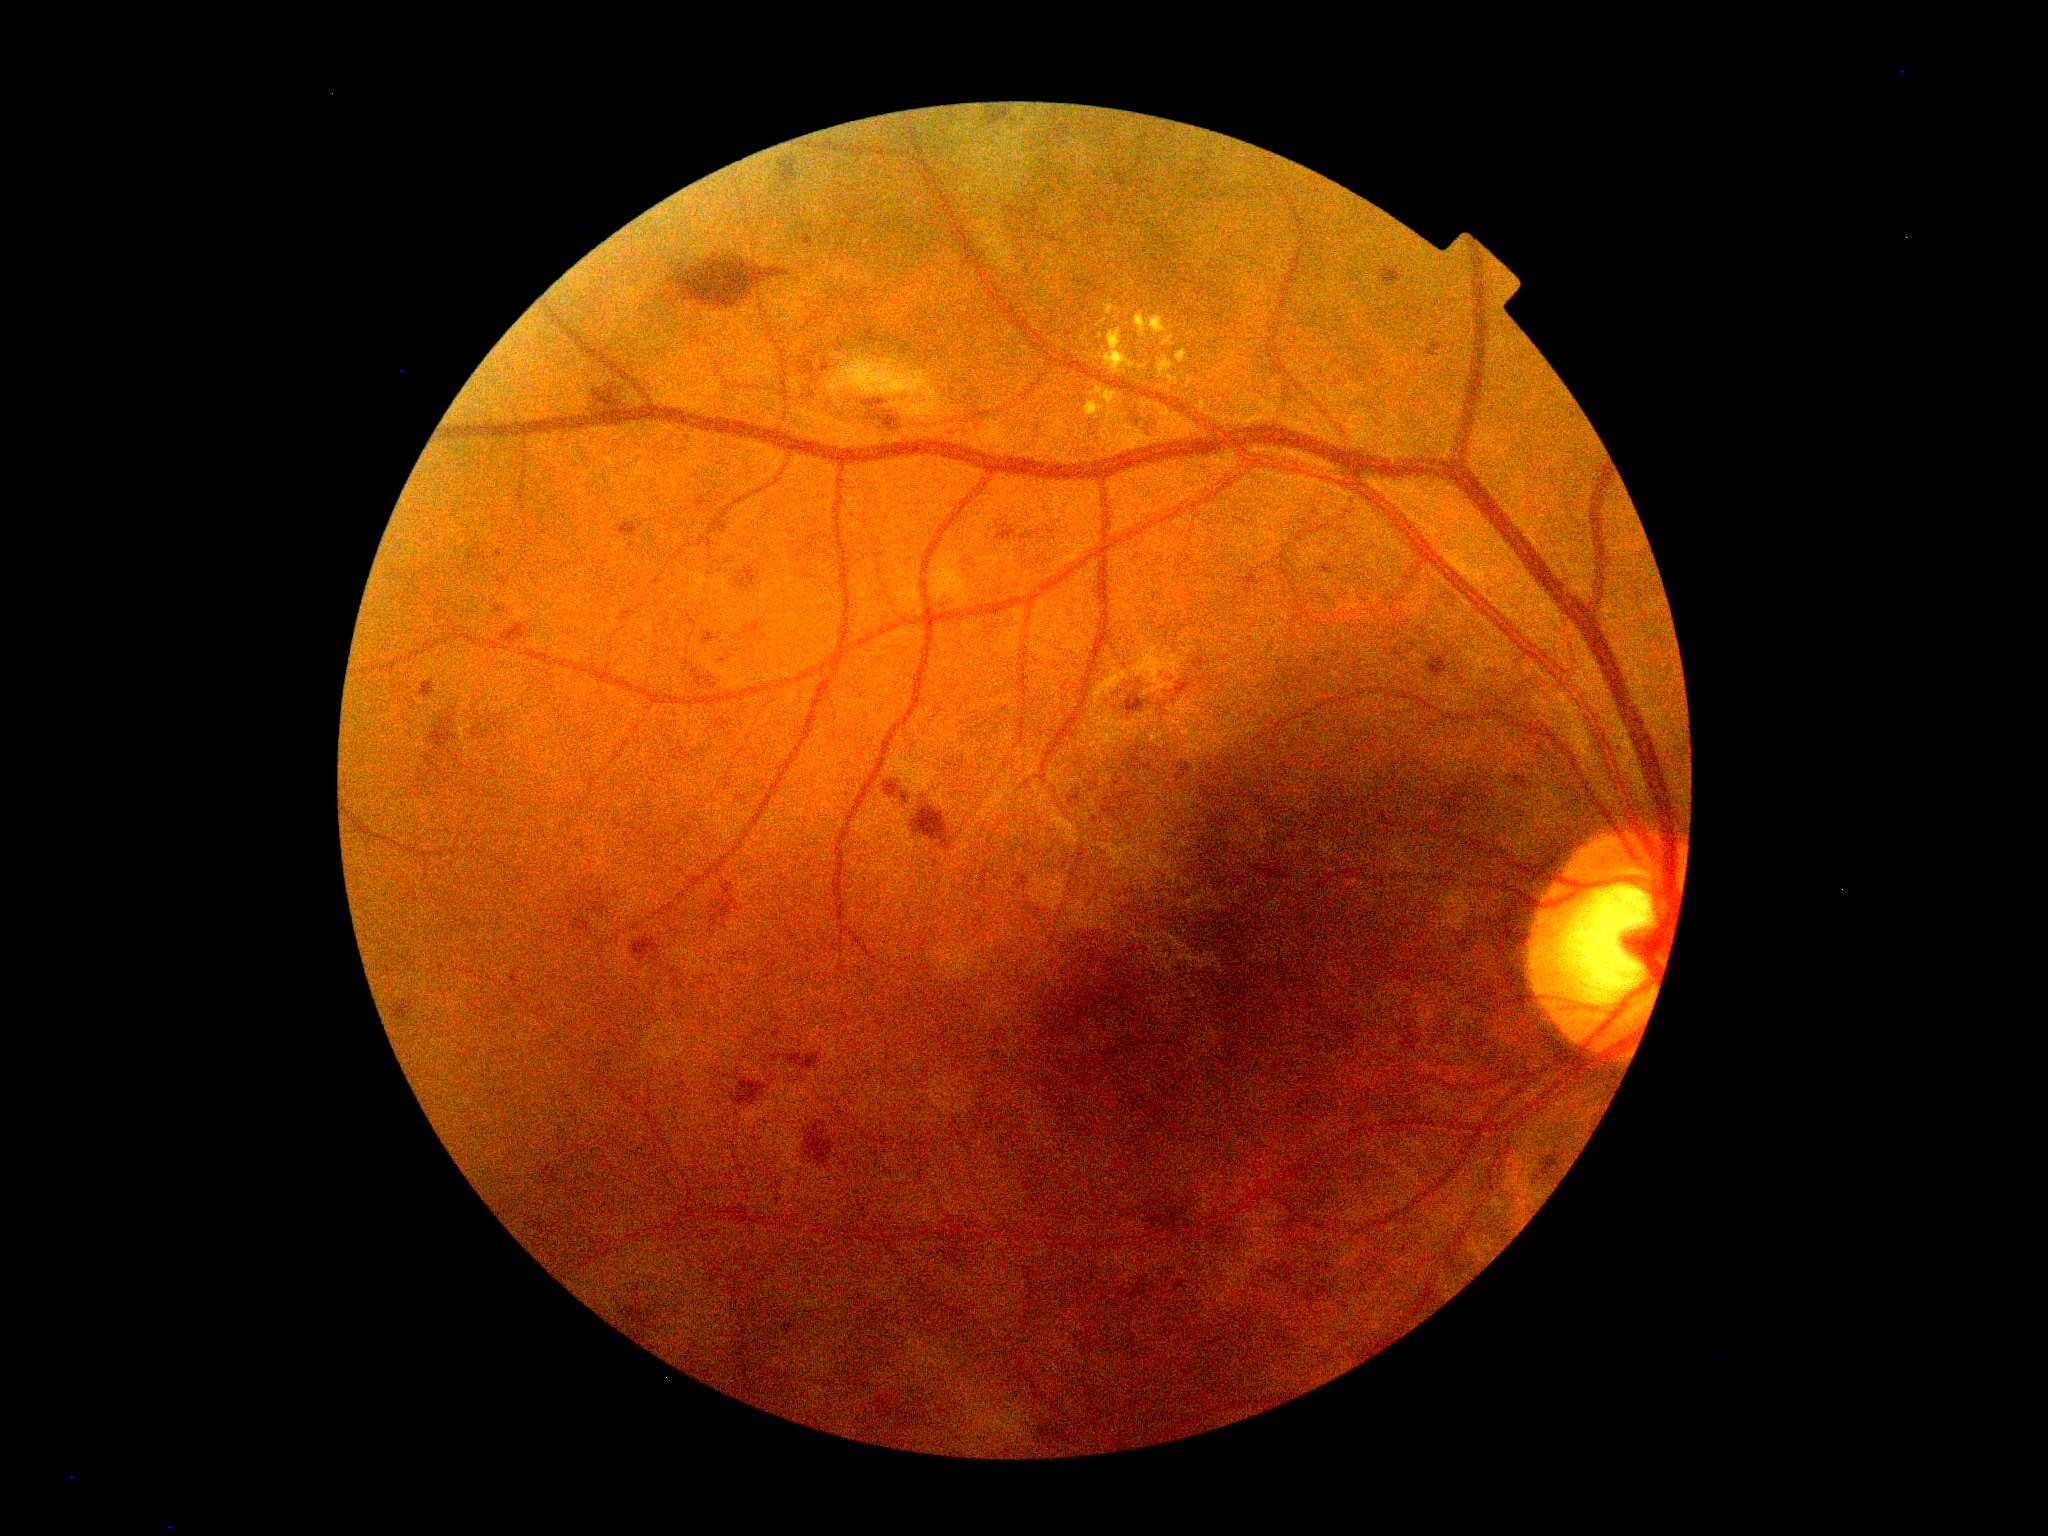
Diabetic retinopathy (DR): moderate NPDR (grade 2).